Pediatric wide-field fundus photograph. 640x480px
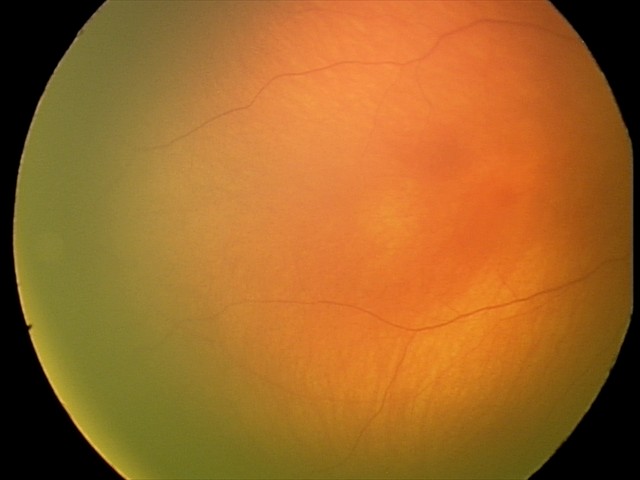

Examination with physiological retinal findings.